Diabetic retinopathy graded by the modified Davis classification — 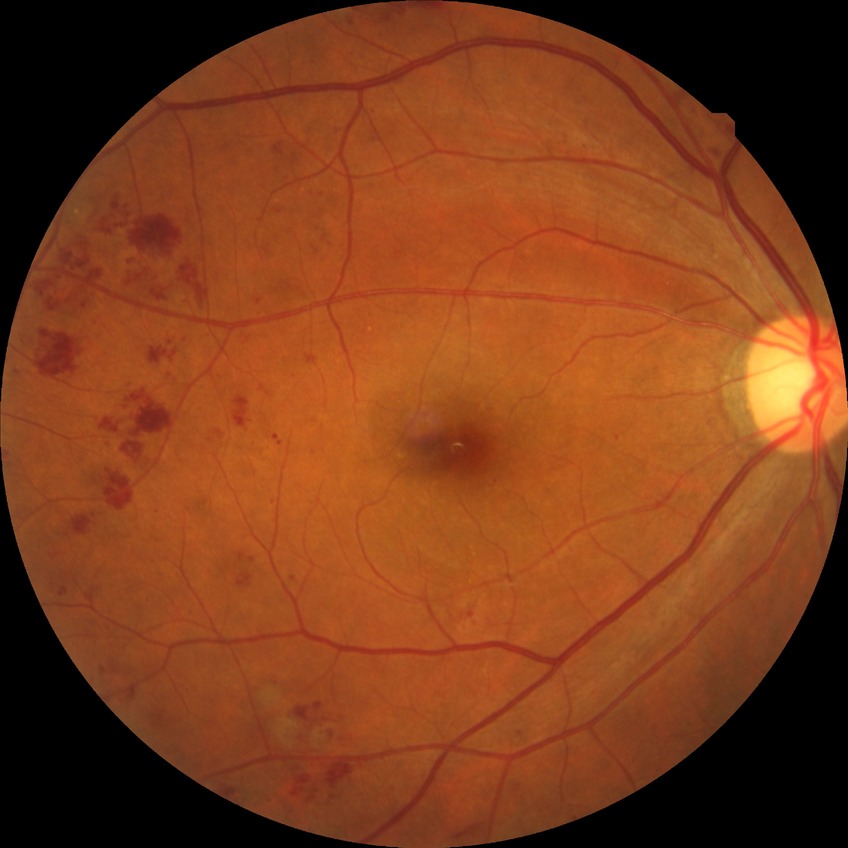

Diabetic retinopathy (DR) is PPDR (pre-proliferative diabetic retinopathy). The retinopathy is classified as non-proliferative diabetic retinopathy.